Modified Davis grading; nonmydriatic fundus photograph; 848x848:
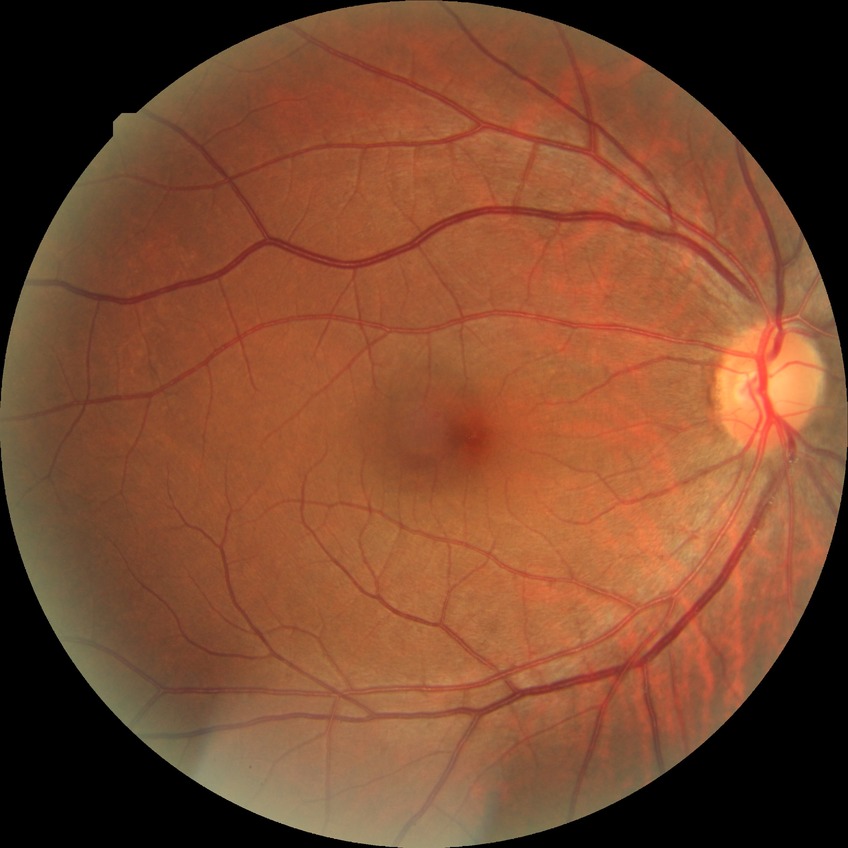 Retinopathy stage is no diabetic retinopathy.